2352 by 1568 pixels:
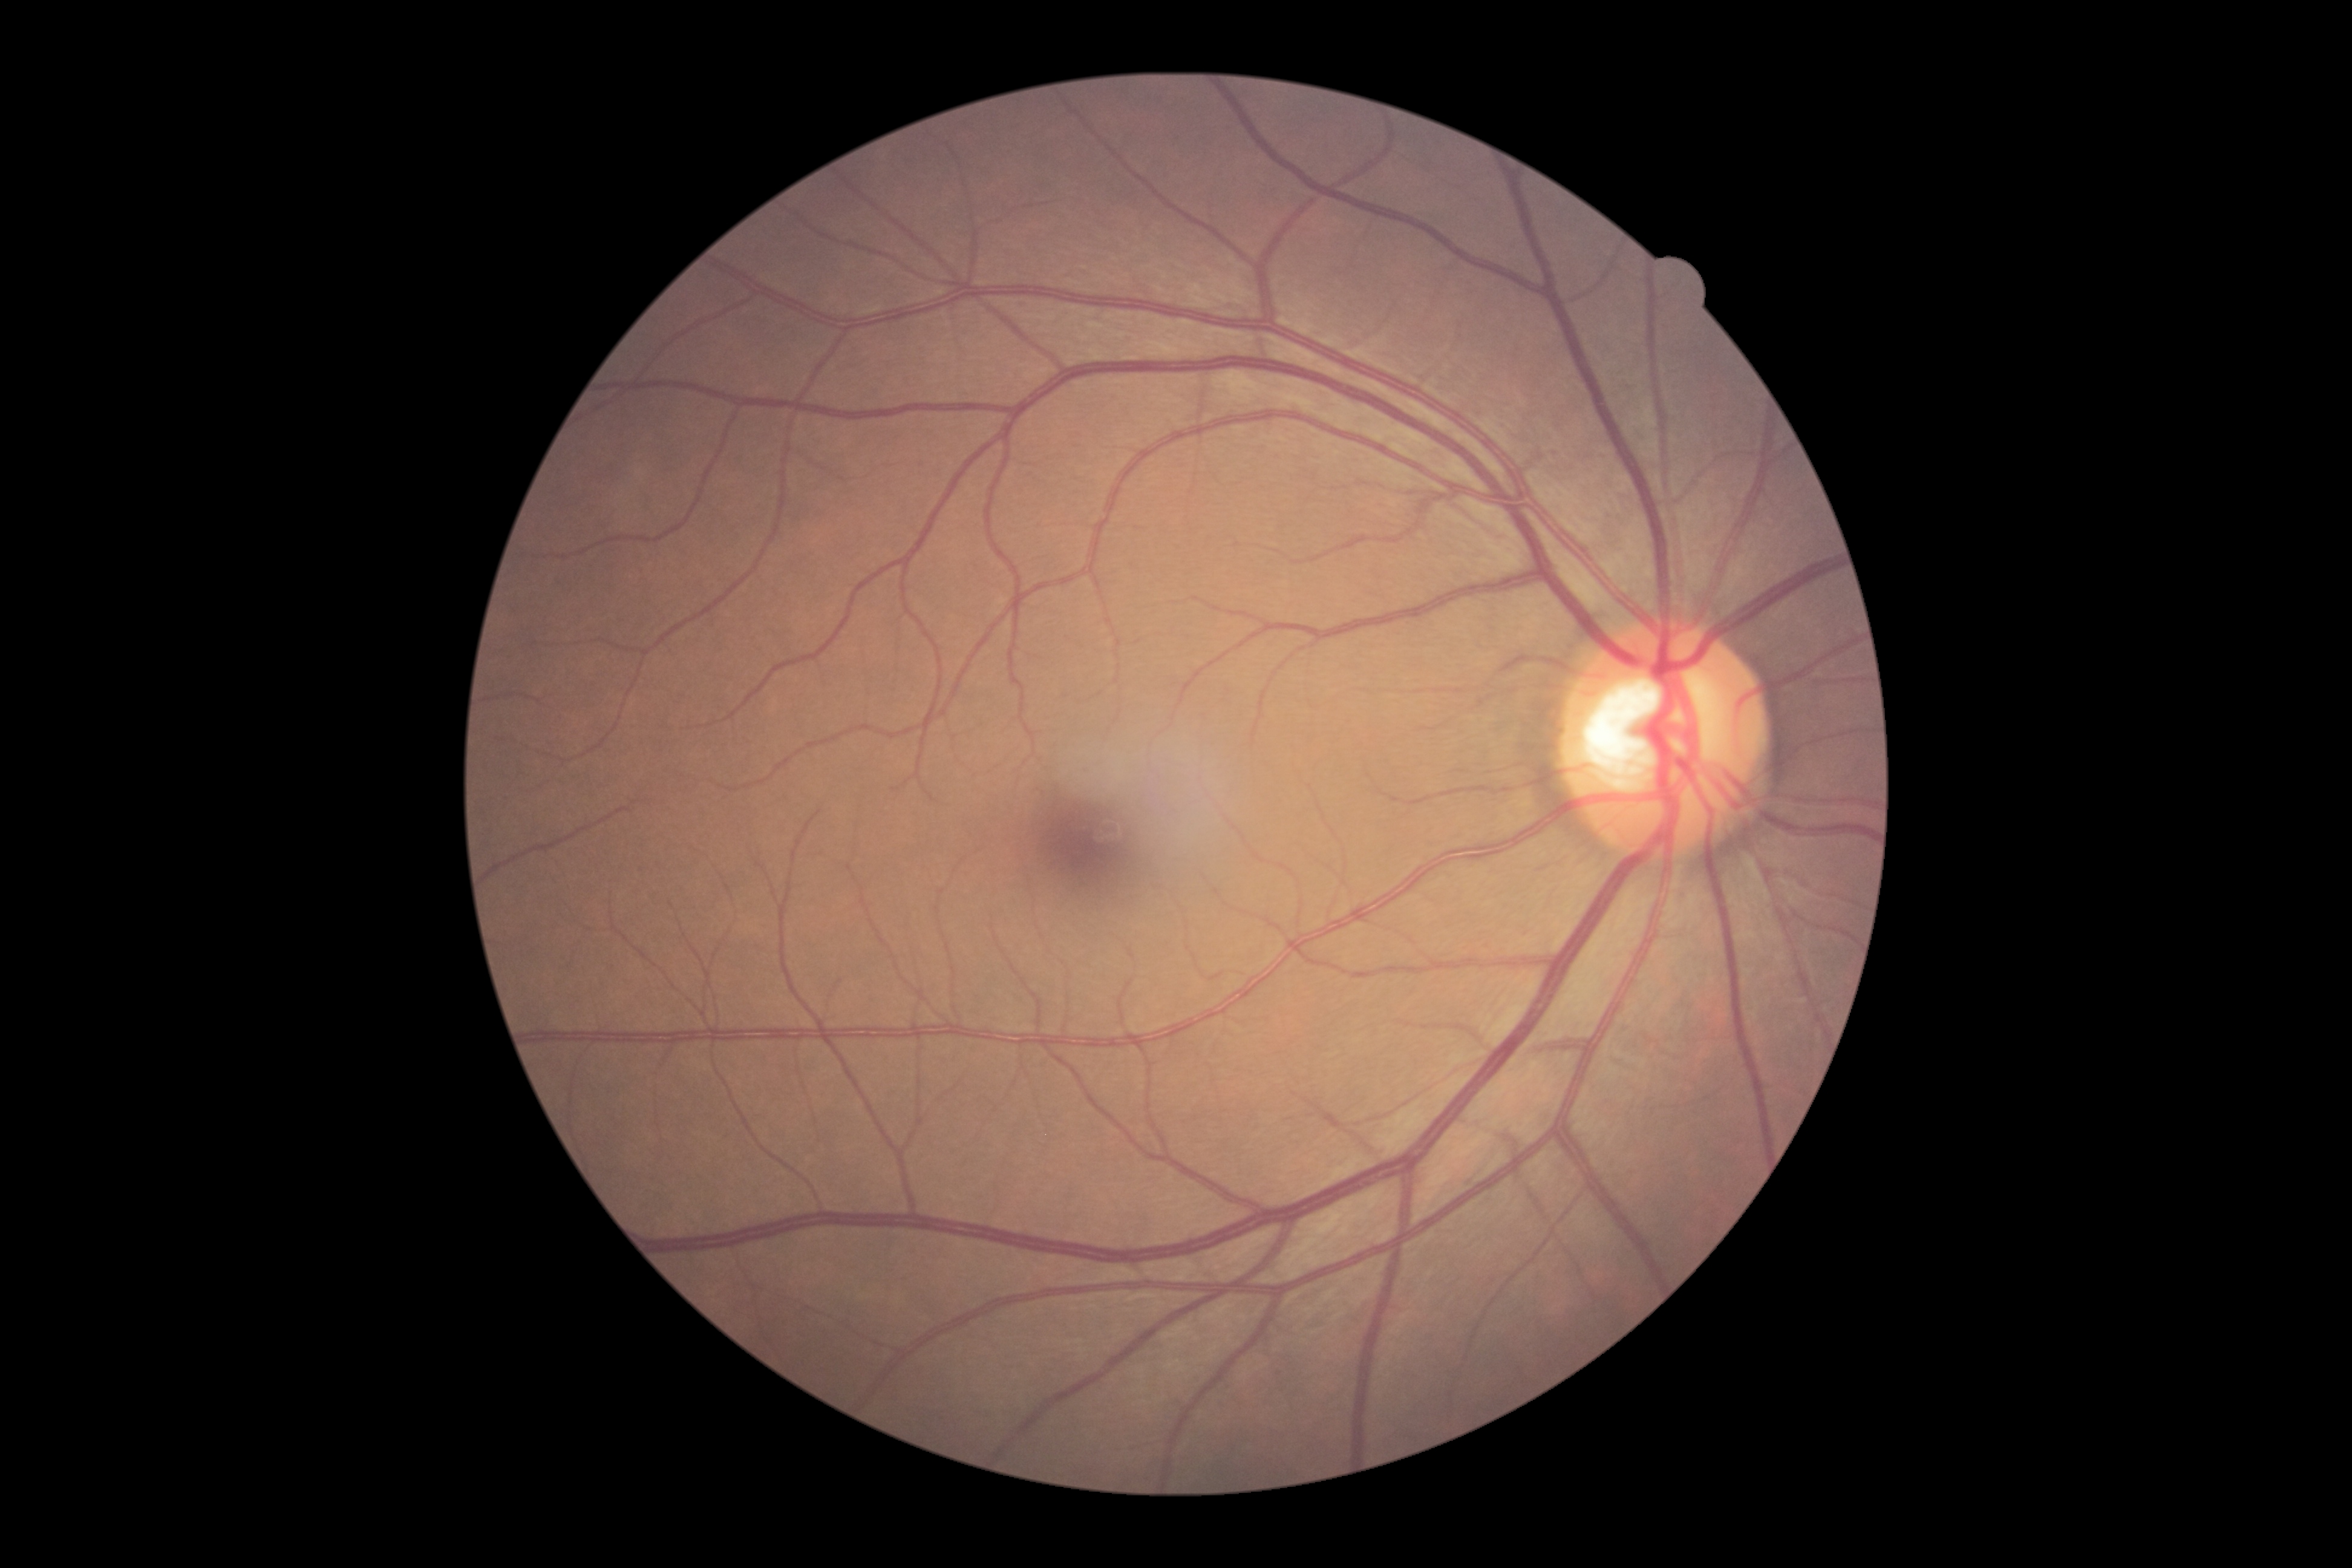 Annotations:
• diabetic retinopathy (DR): grade 0 (no apparent retinopathy)